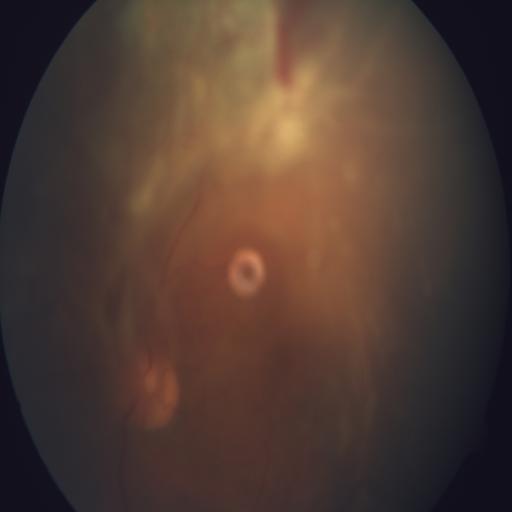

Color fundus photograph showing retinal traction and hemorrhagic retinopathy.